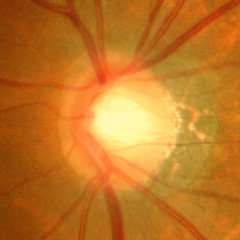
The image shows severe glaucomatous damage.